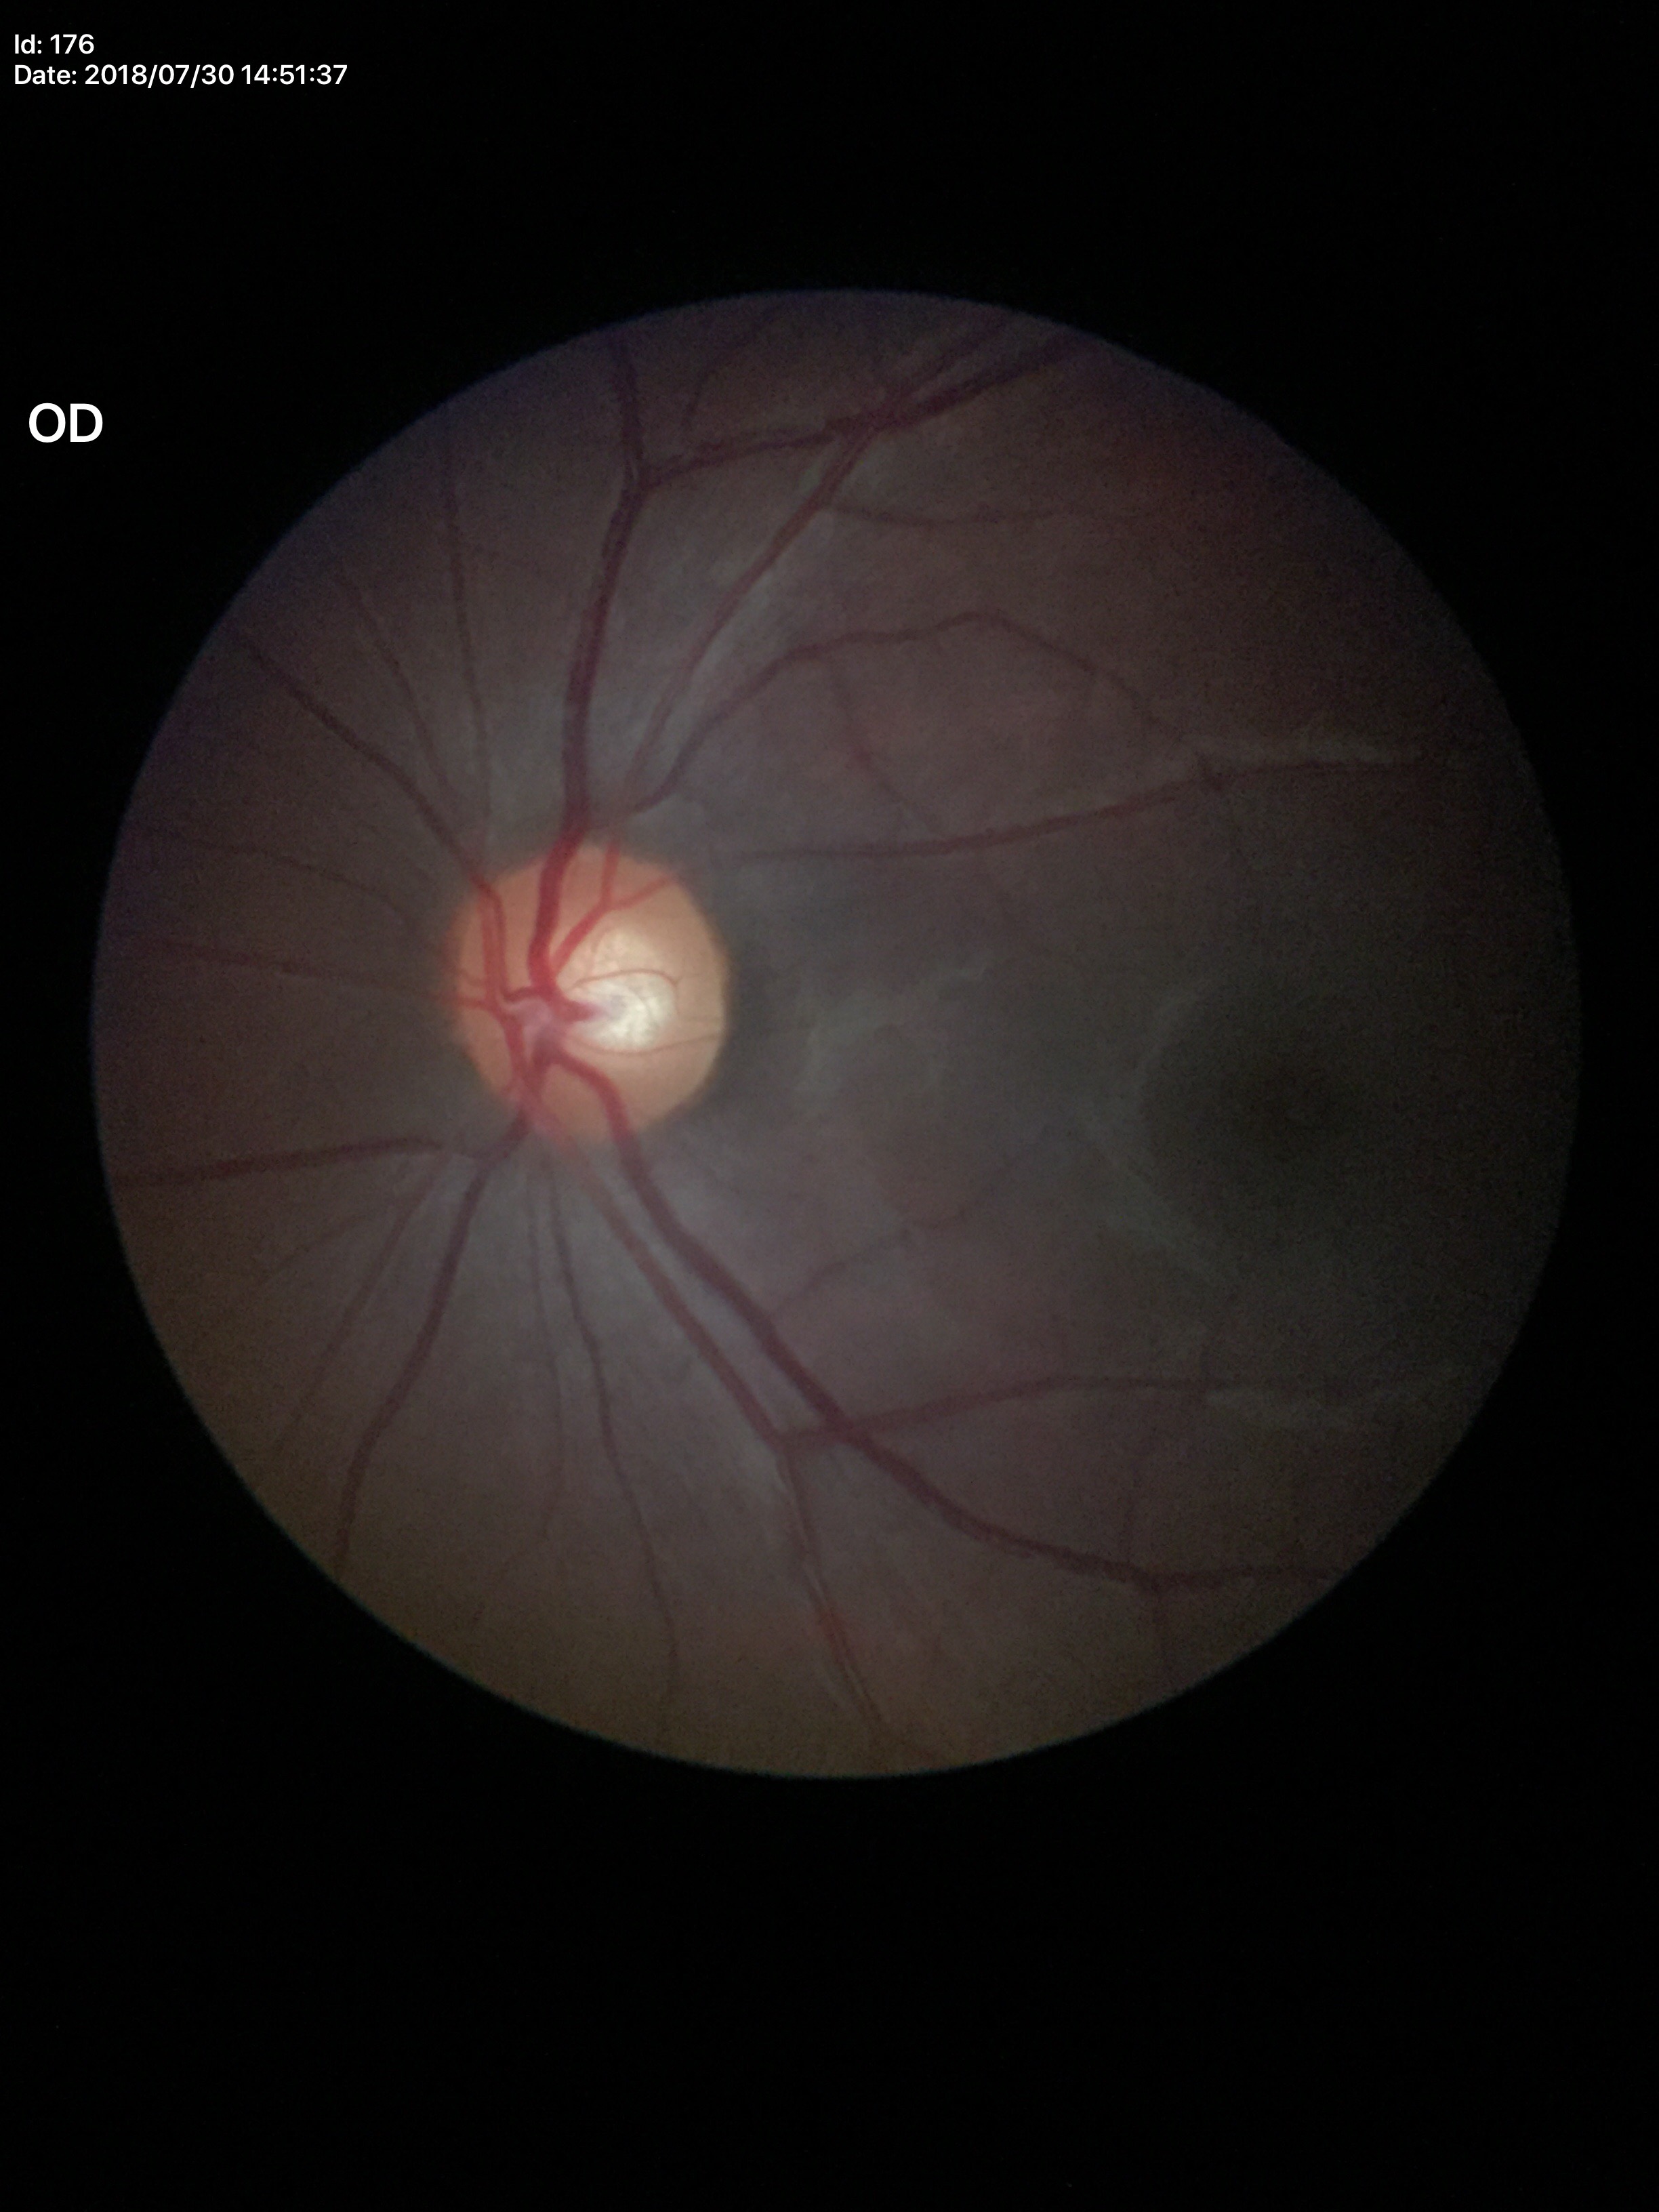 Negative for glaucoma suspicion. Vertical cup-disc ratio of 0.55. Area cup-disc ratio: 0.34.